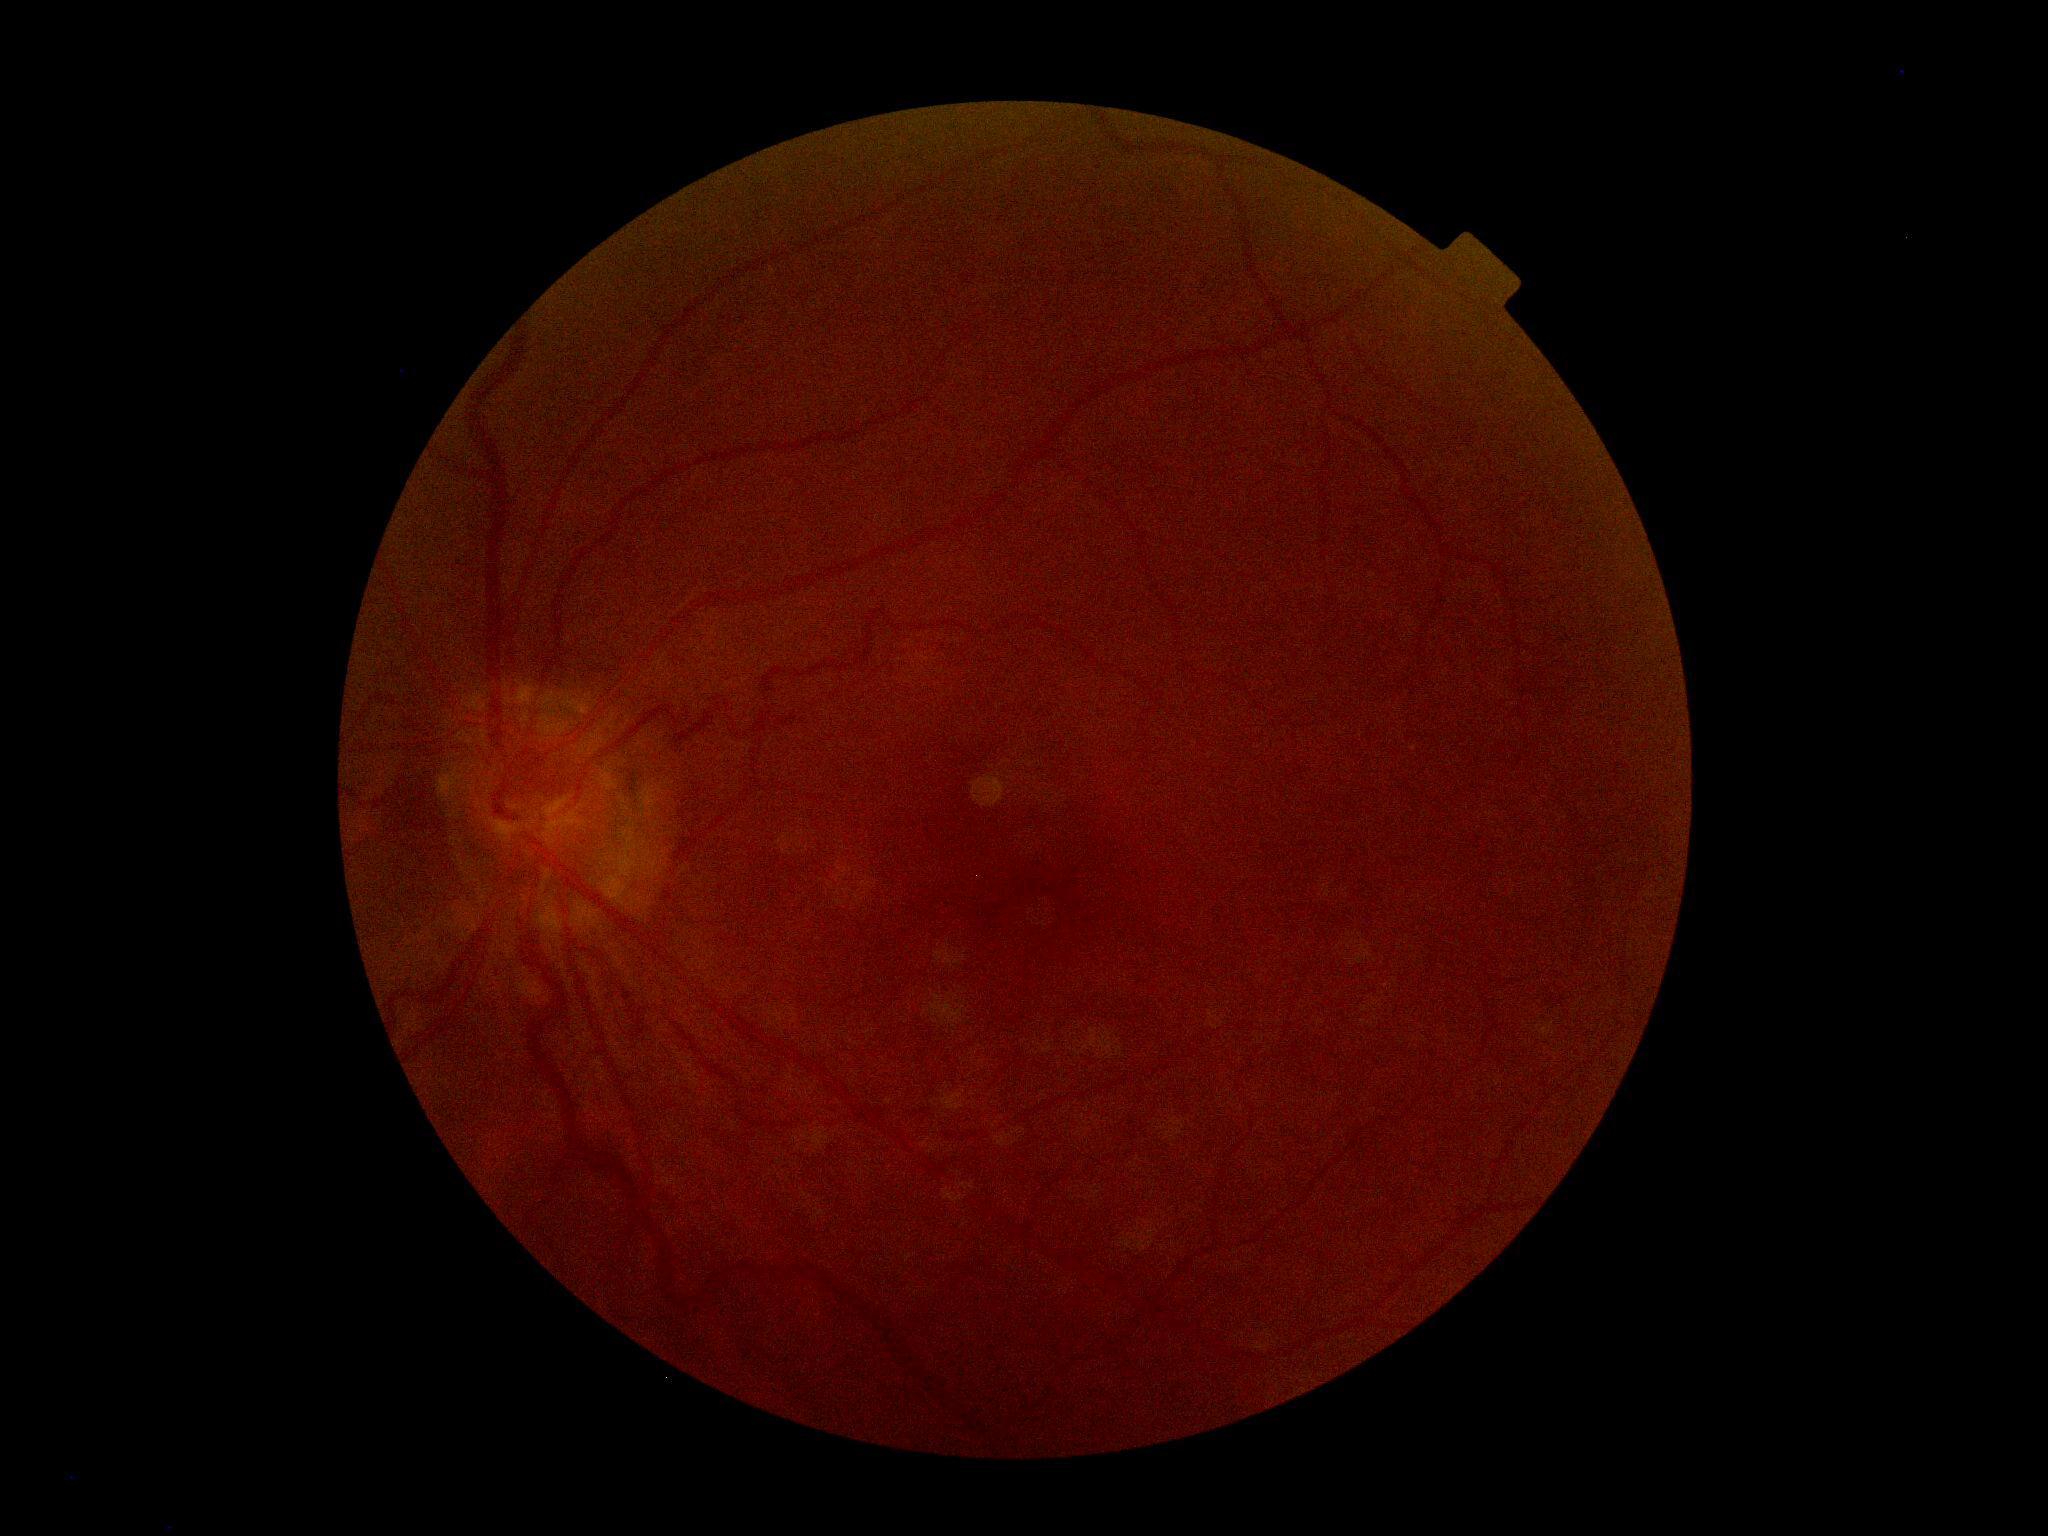
DR stage = ungradable, image quality = too poor for DR grading.